Centered on the macula — 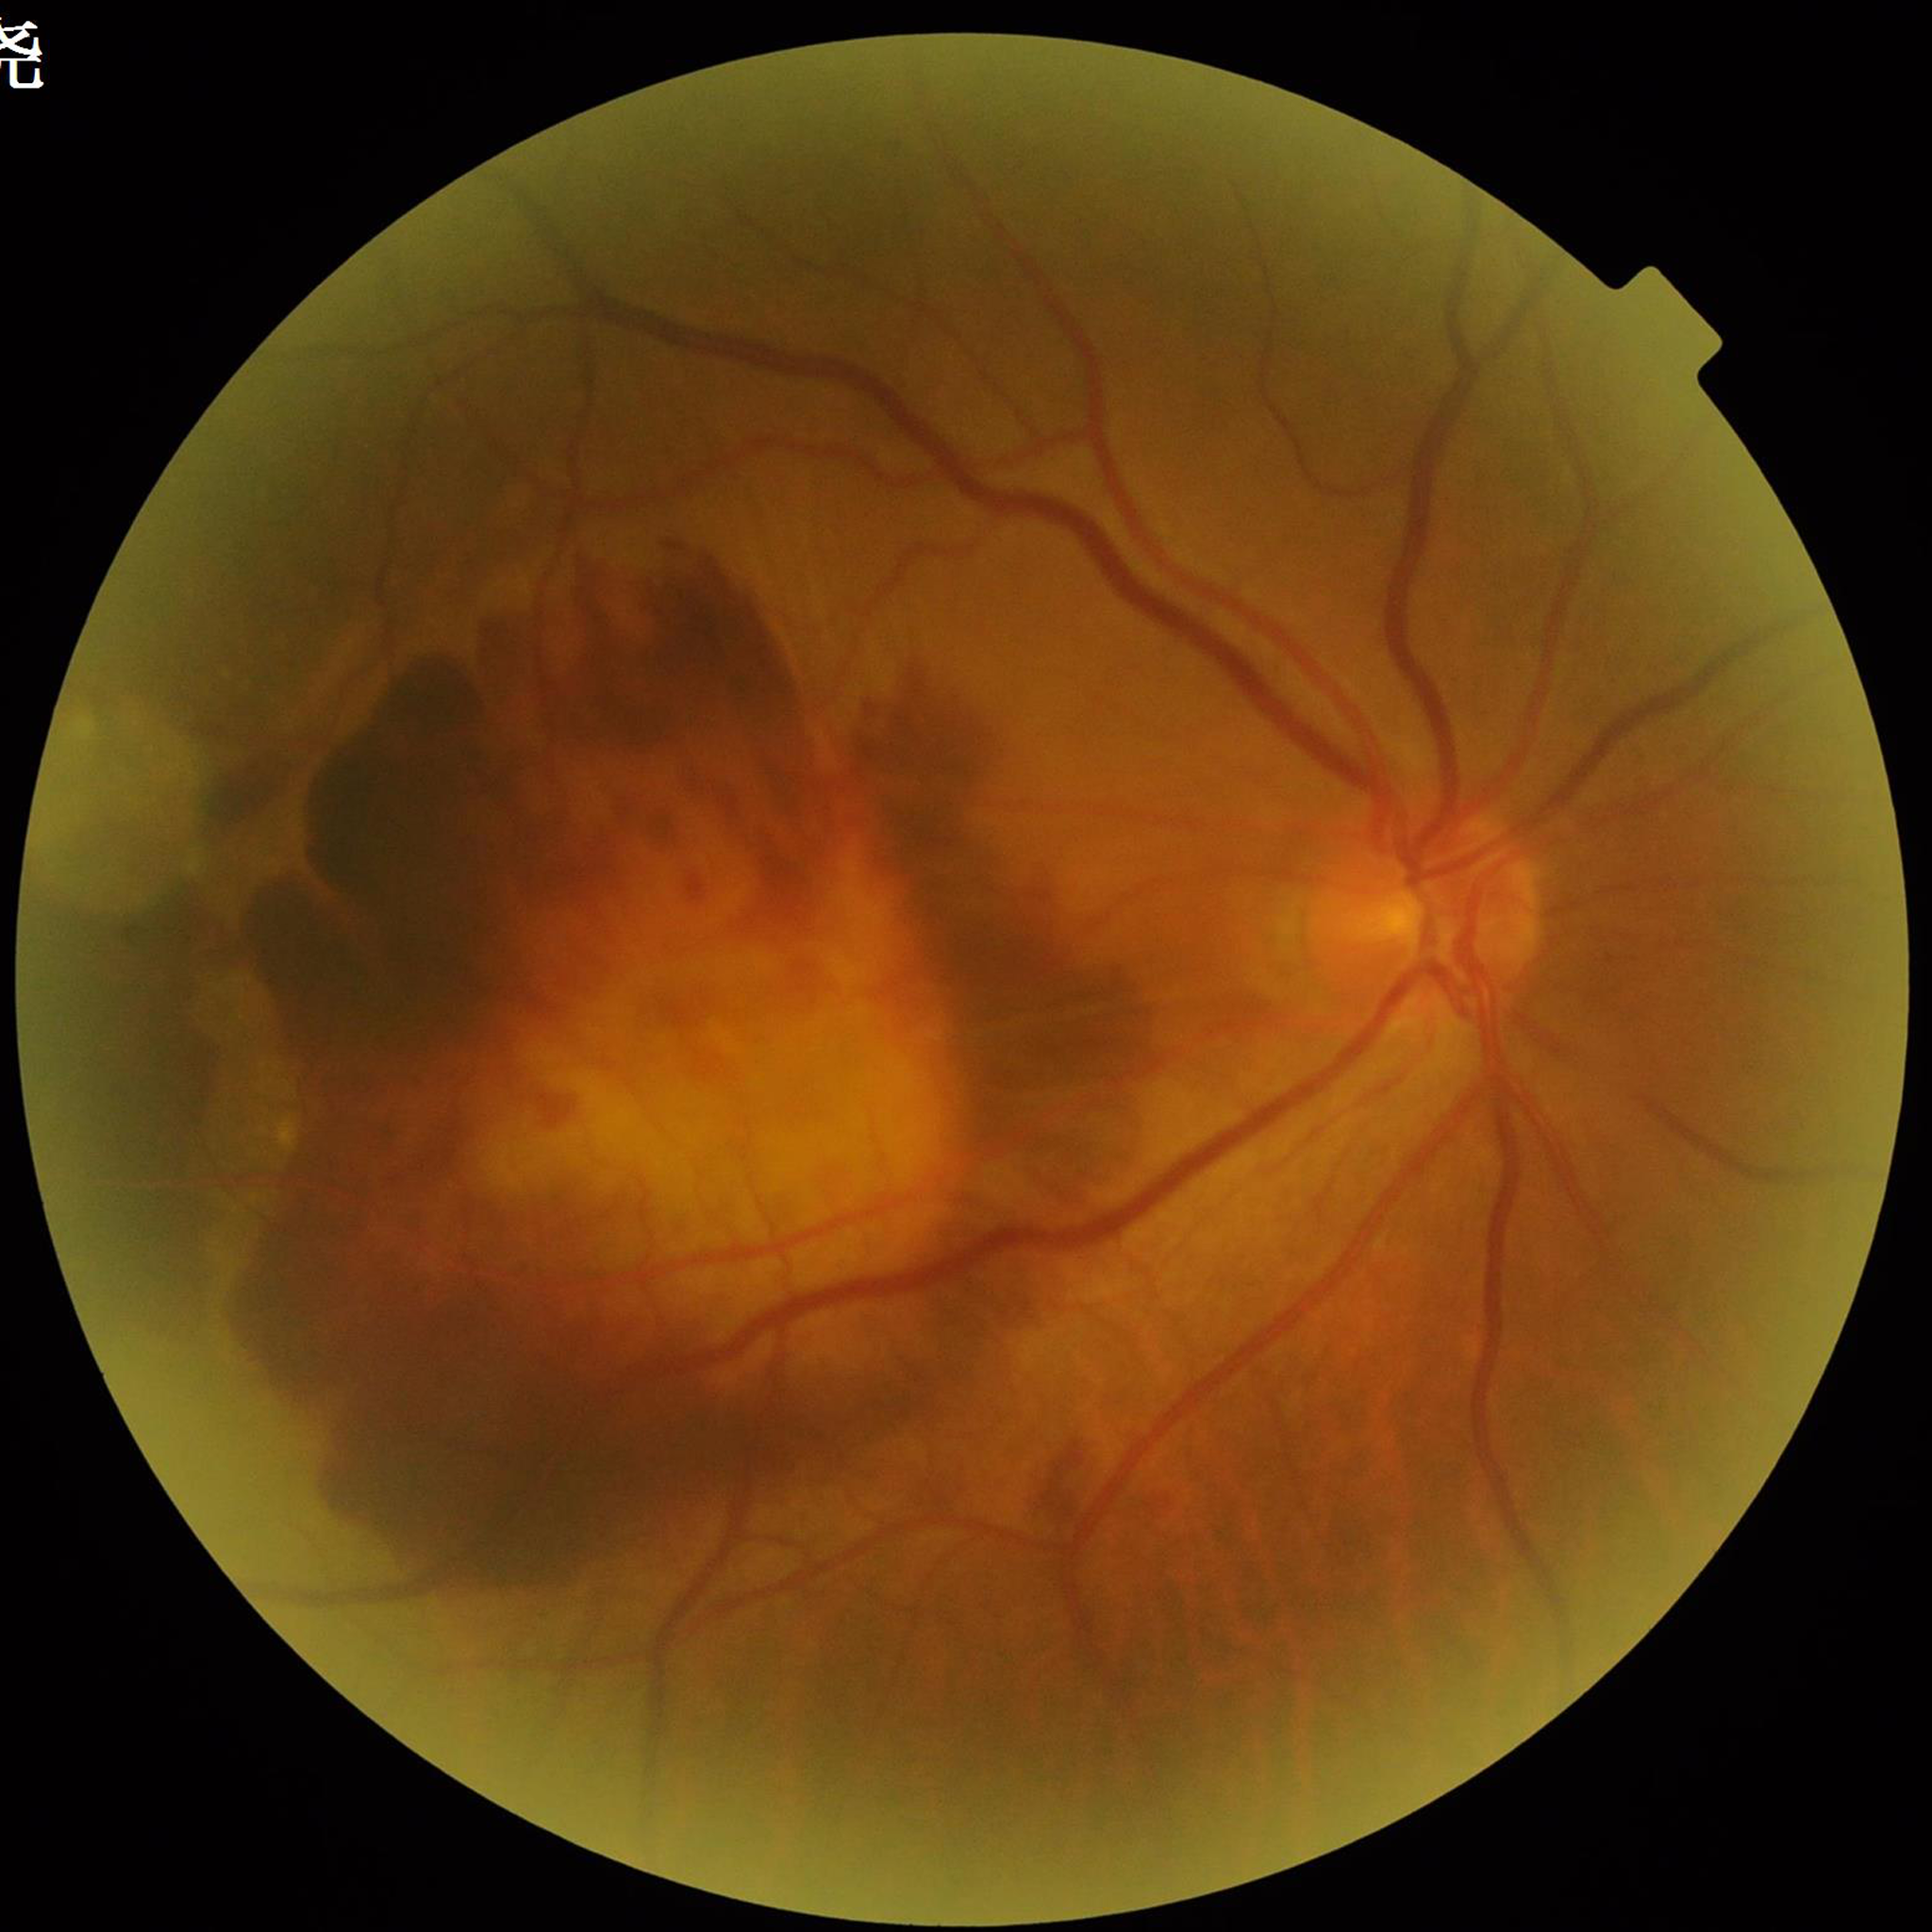 Diagnosis: AMD | Quality assessment: suboptimal — illumination/color distortion.